Without pupil dilation; retinal fundus photograph; 848x848.
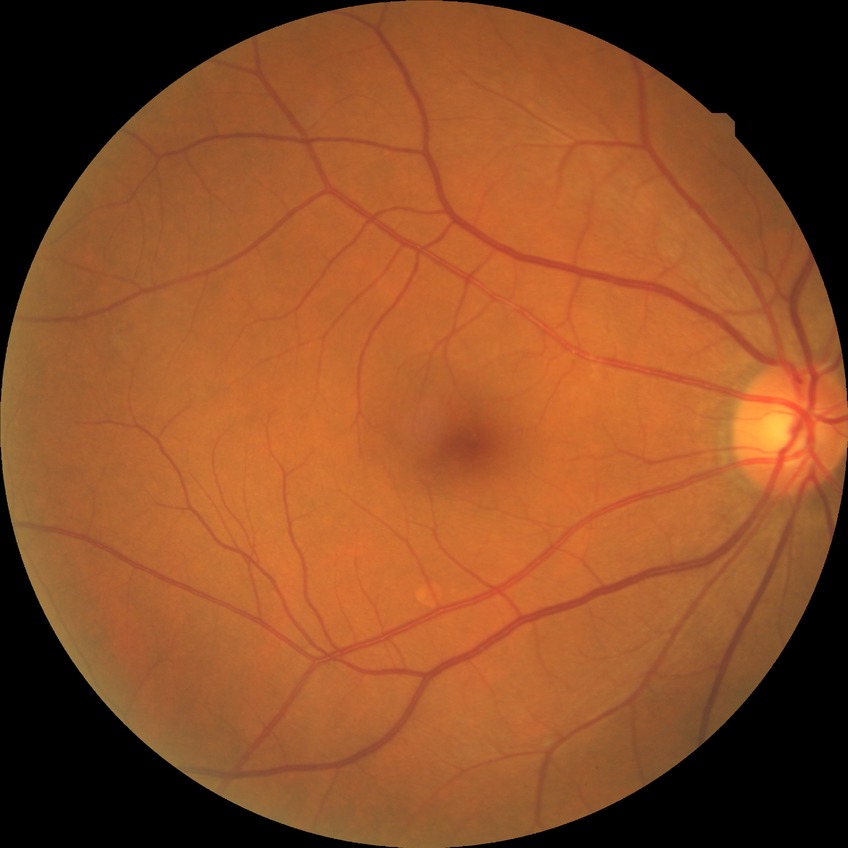 Retinopathy stage is no diabetic retinopathy.